Fundus photo.
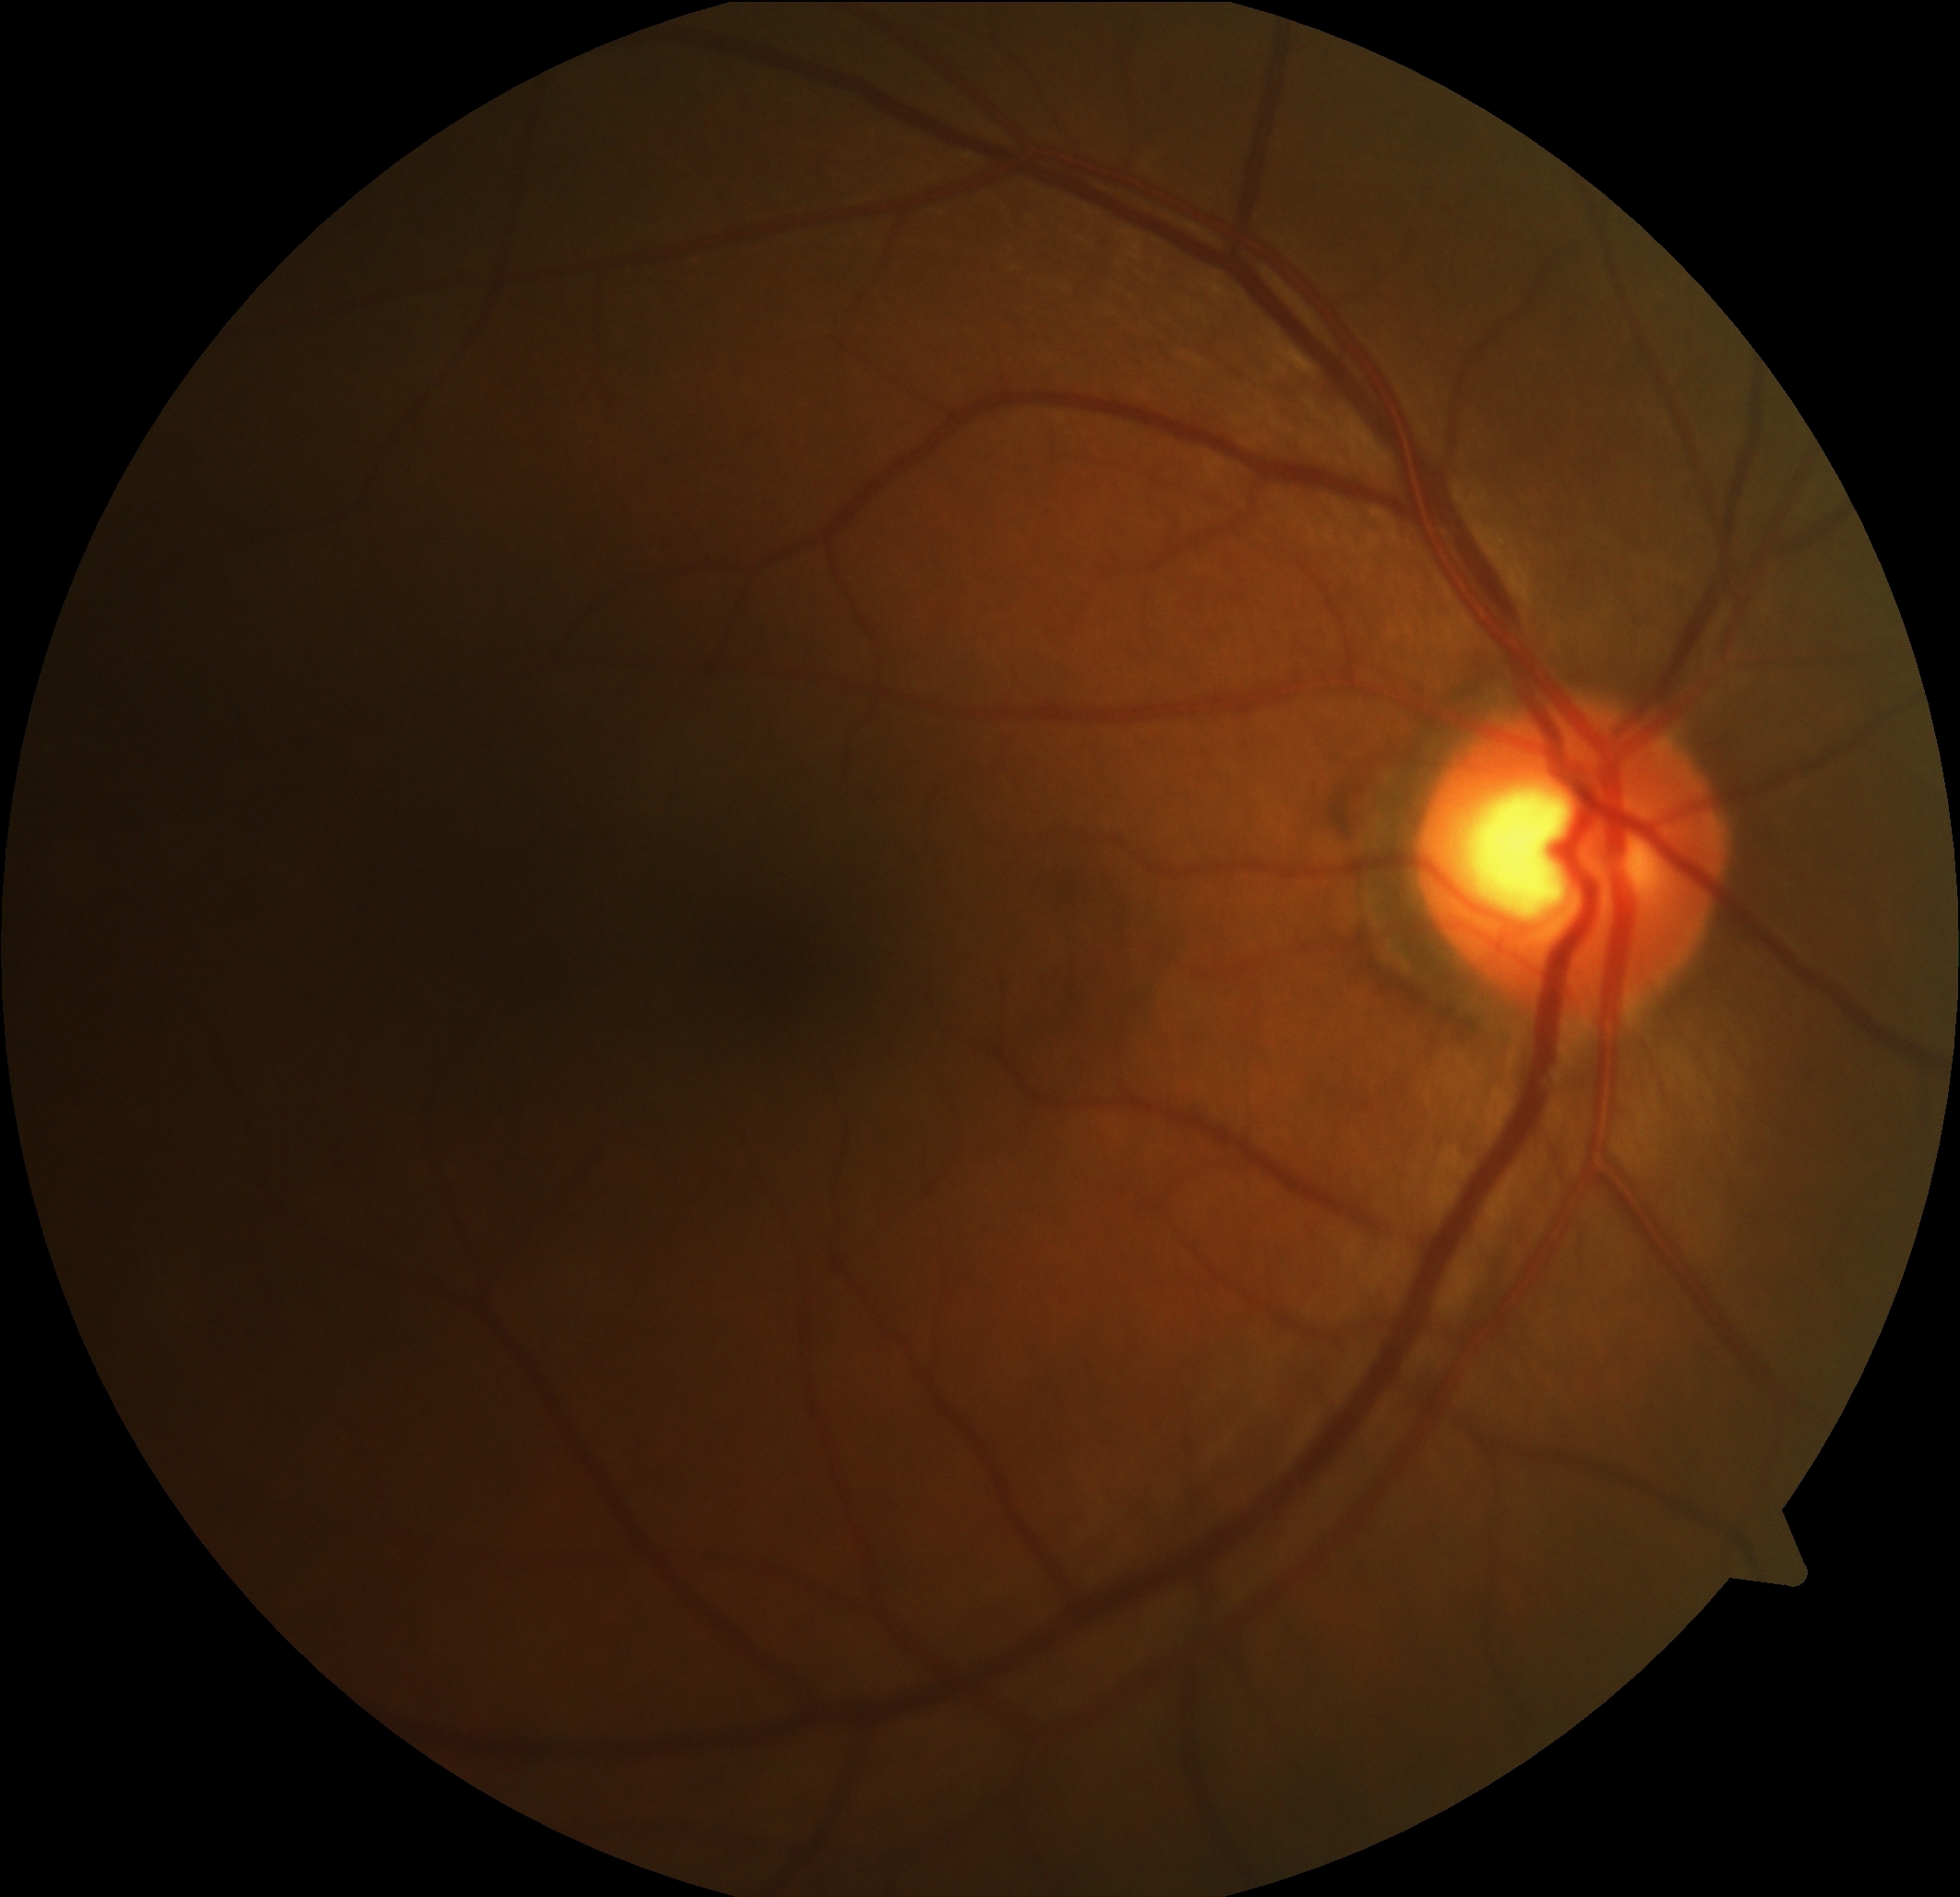

  dr_grade: 0/4 — no visible signs of diabetic retinopathy